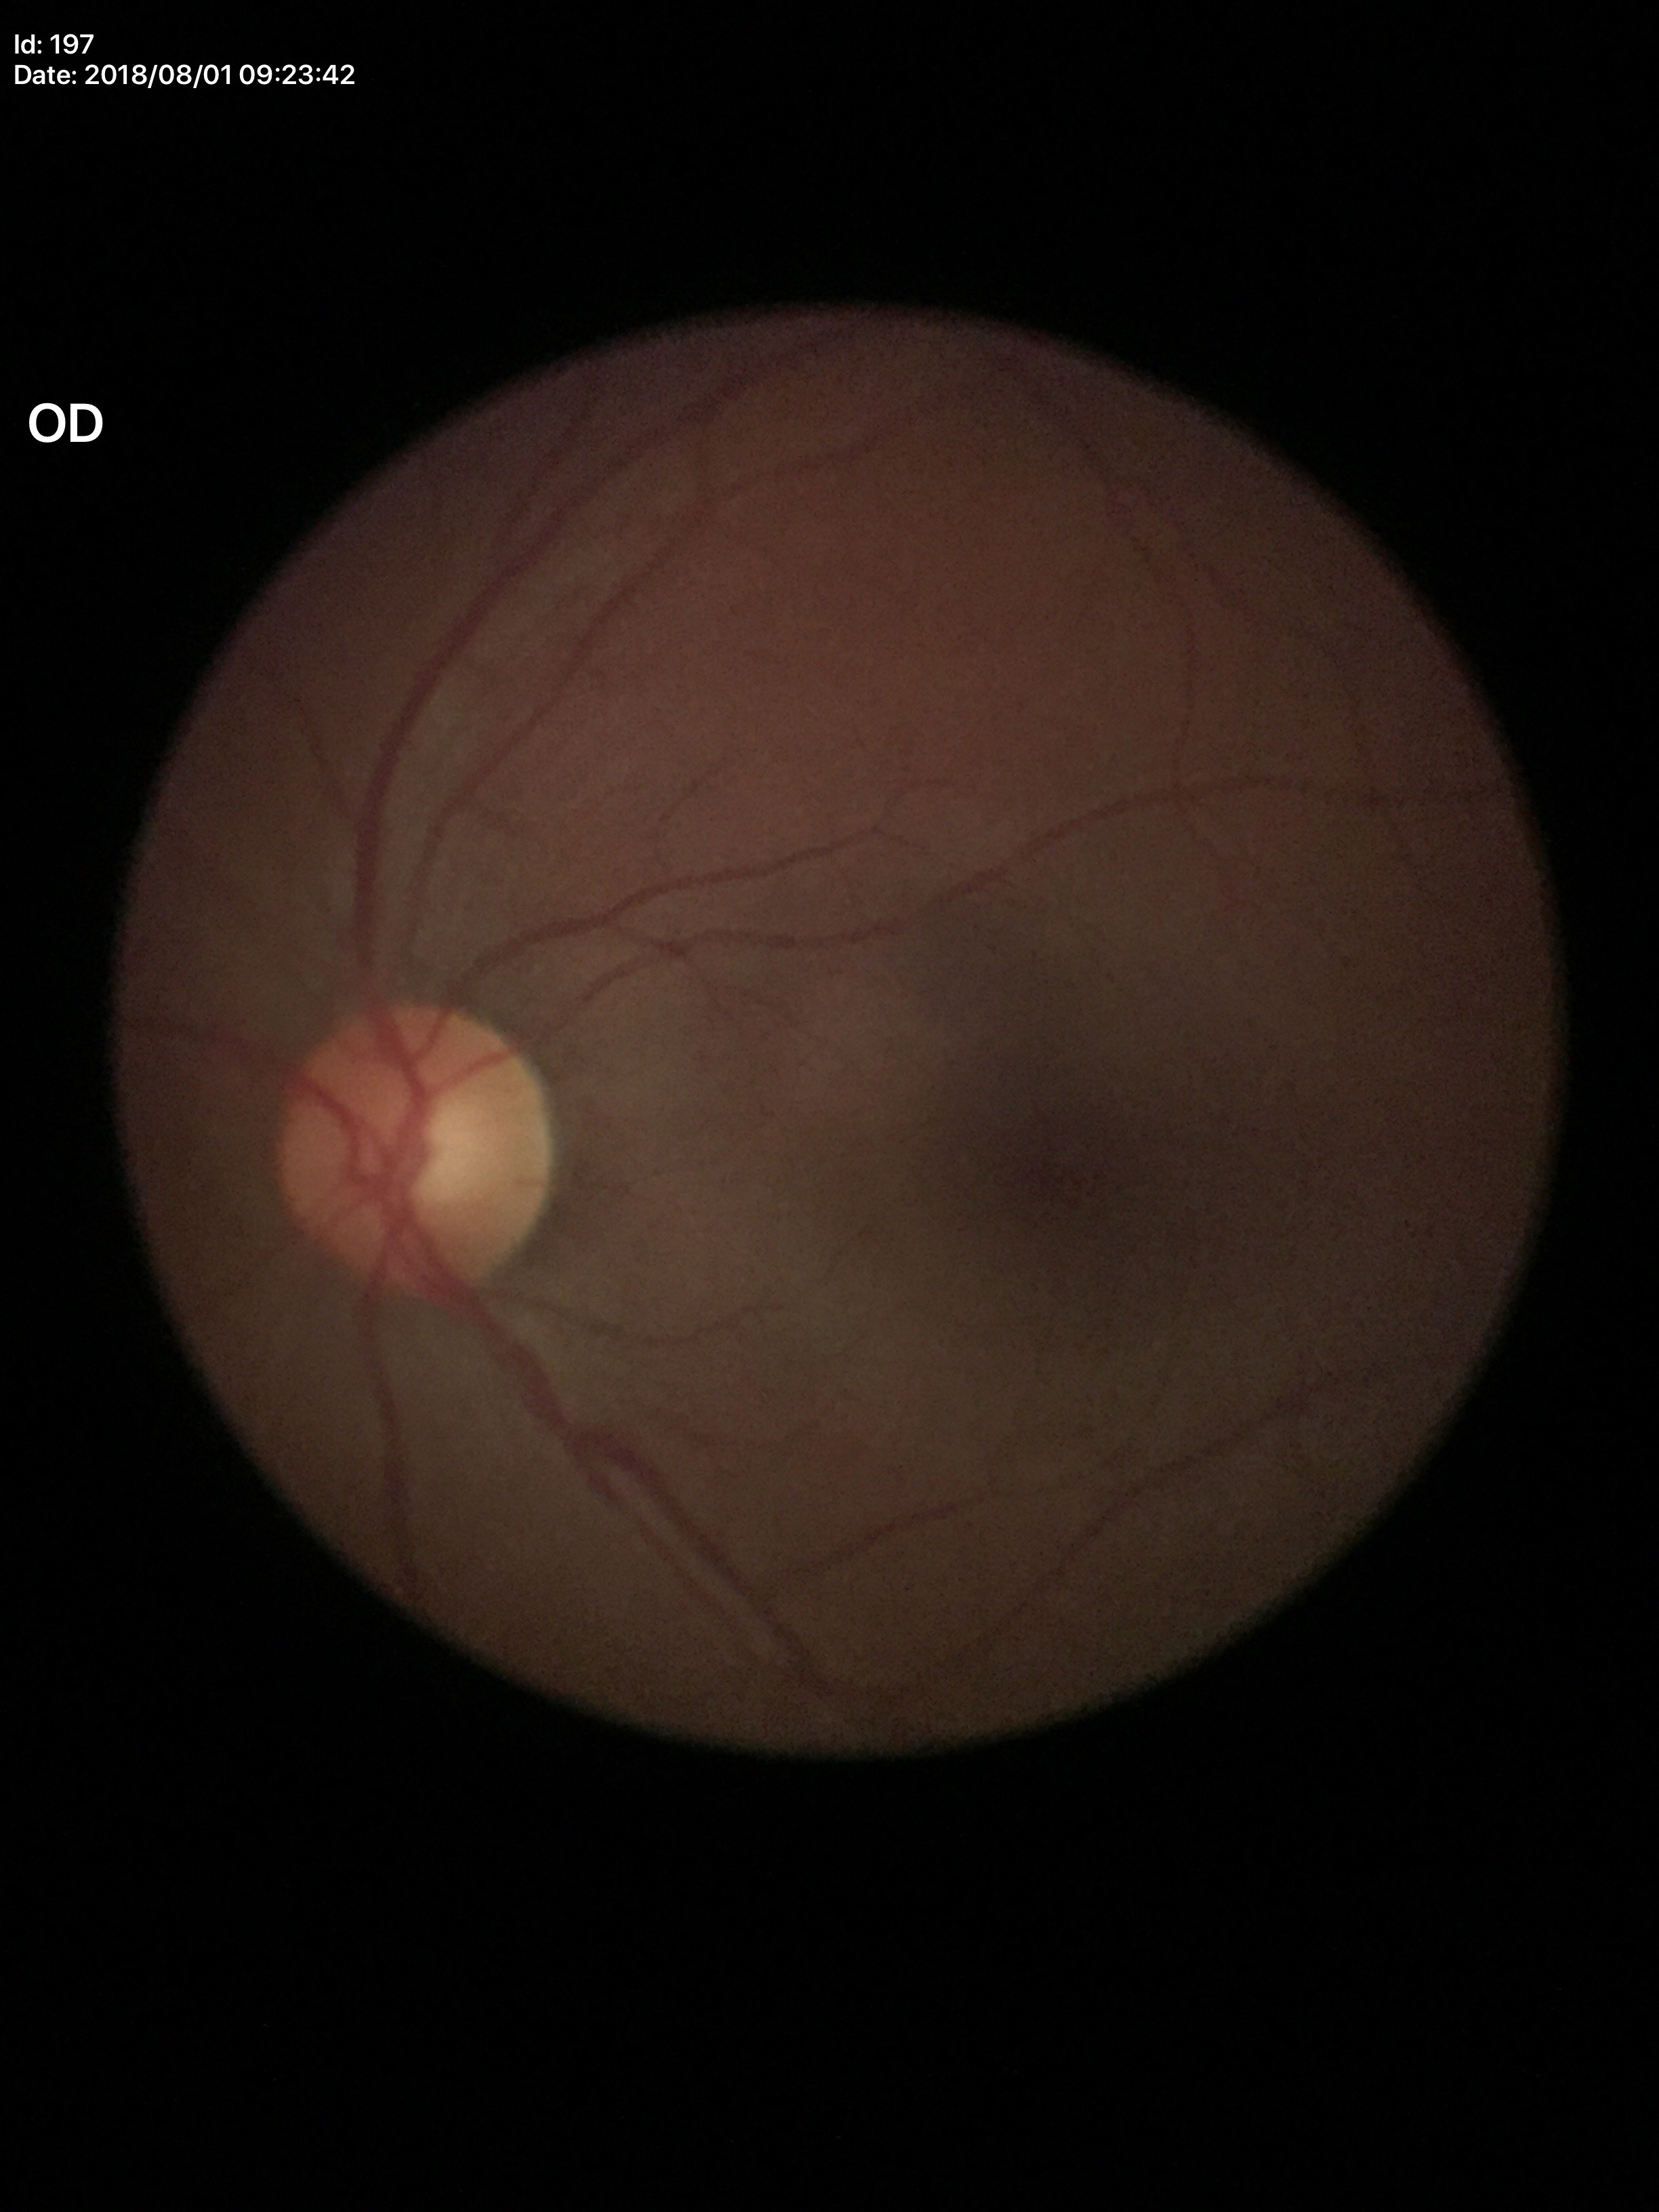 Optic disc analysis:
– Glaucoma evaluation — no suspicious findings (unanimous normal call)
– HCDR — 0.47
– VCDR — 0.50